Infant wide-field fundus photograph. Acquired on the Clarity RetCam 3. 640 by 480 pixels — 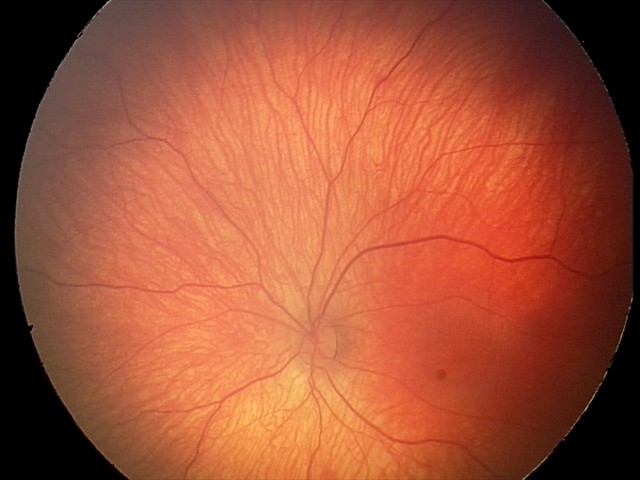
Screening: retinal hemorrhages.